Infant wide-field fundus photograph
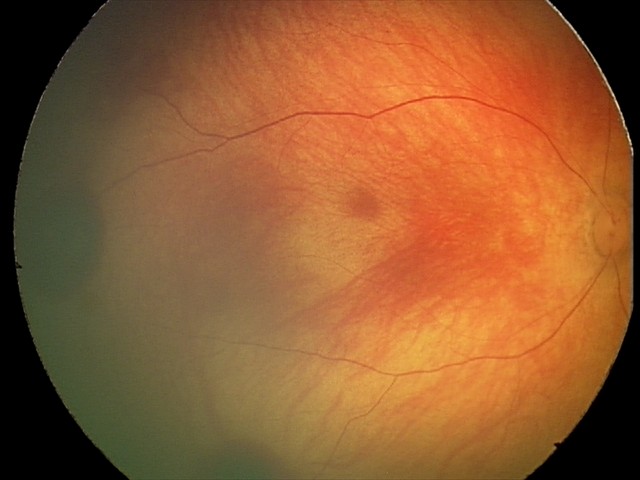

Series diagnosed as retinal hemorrhages.